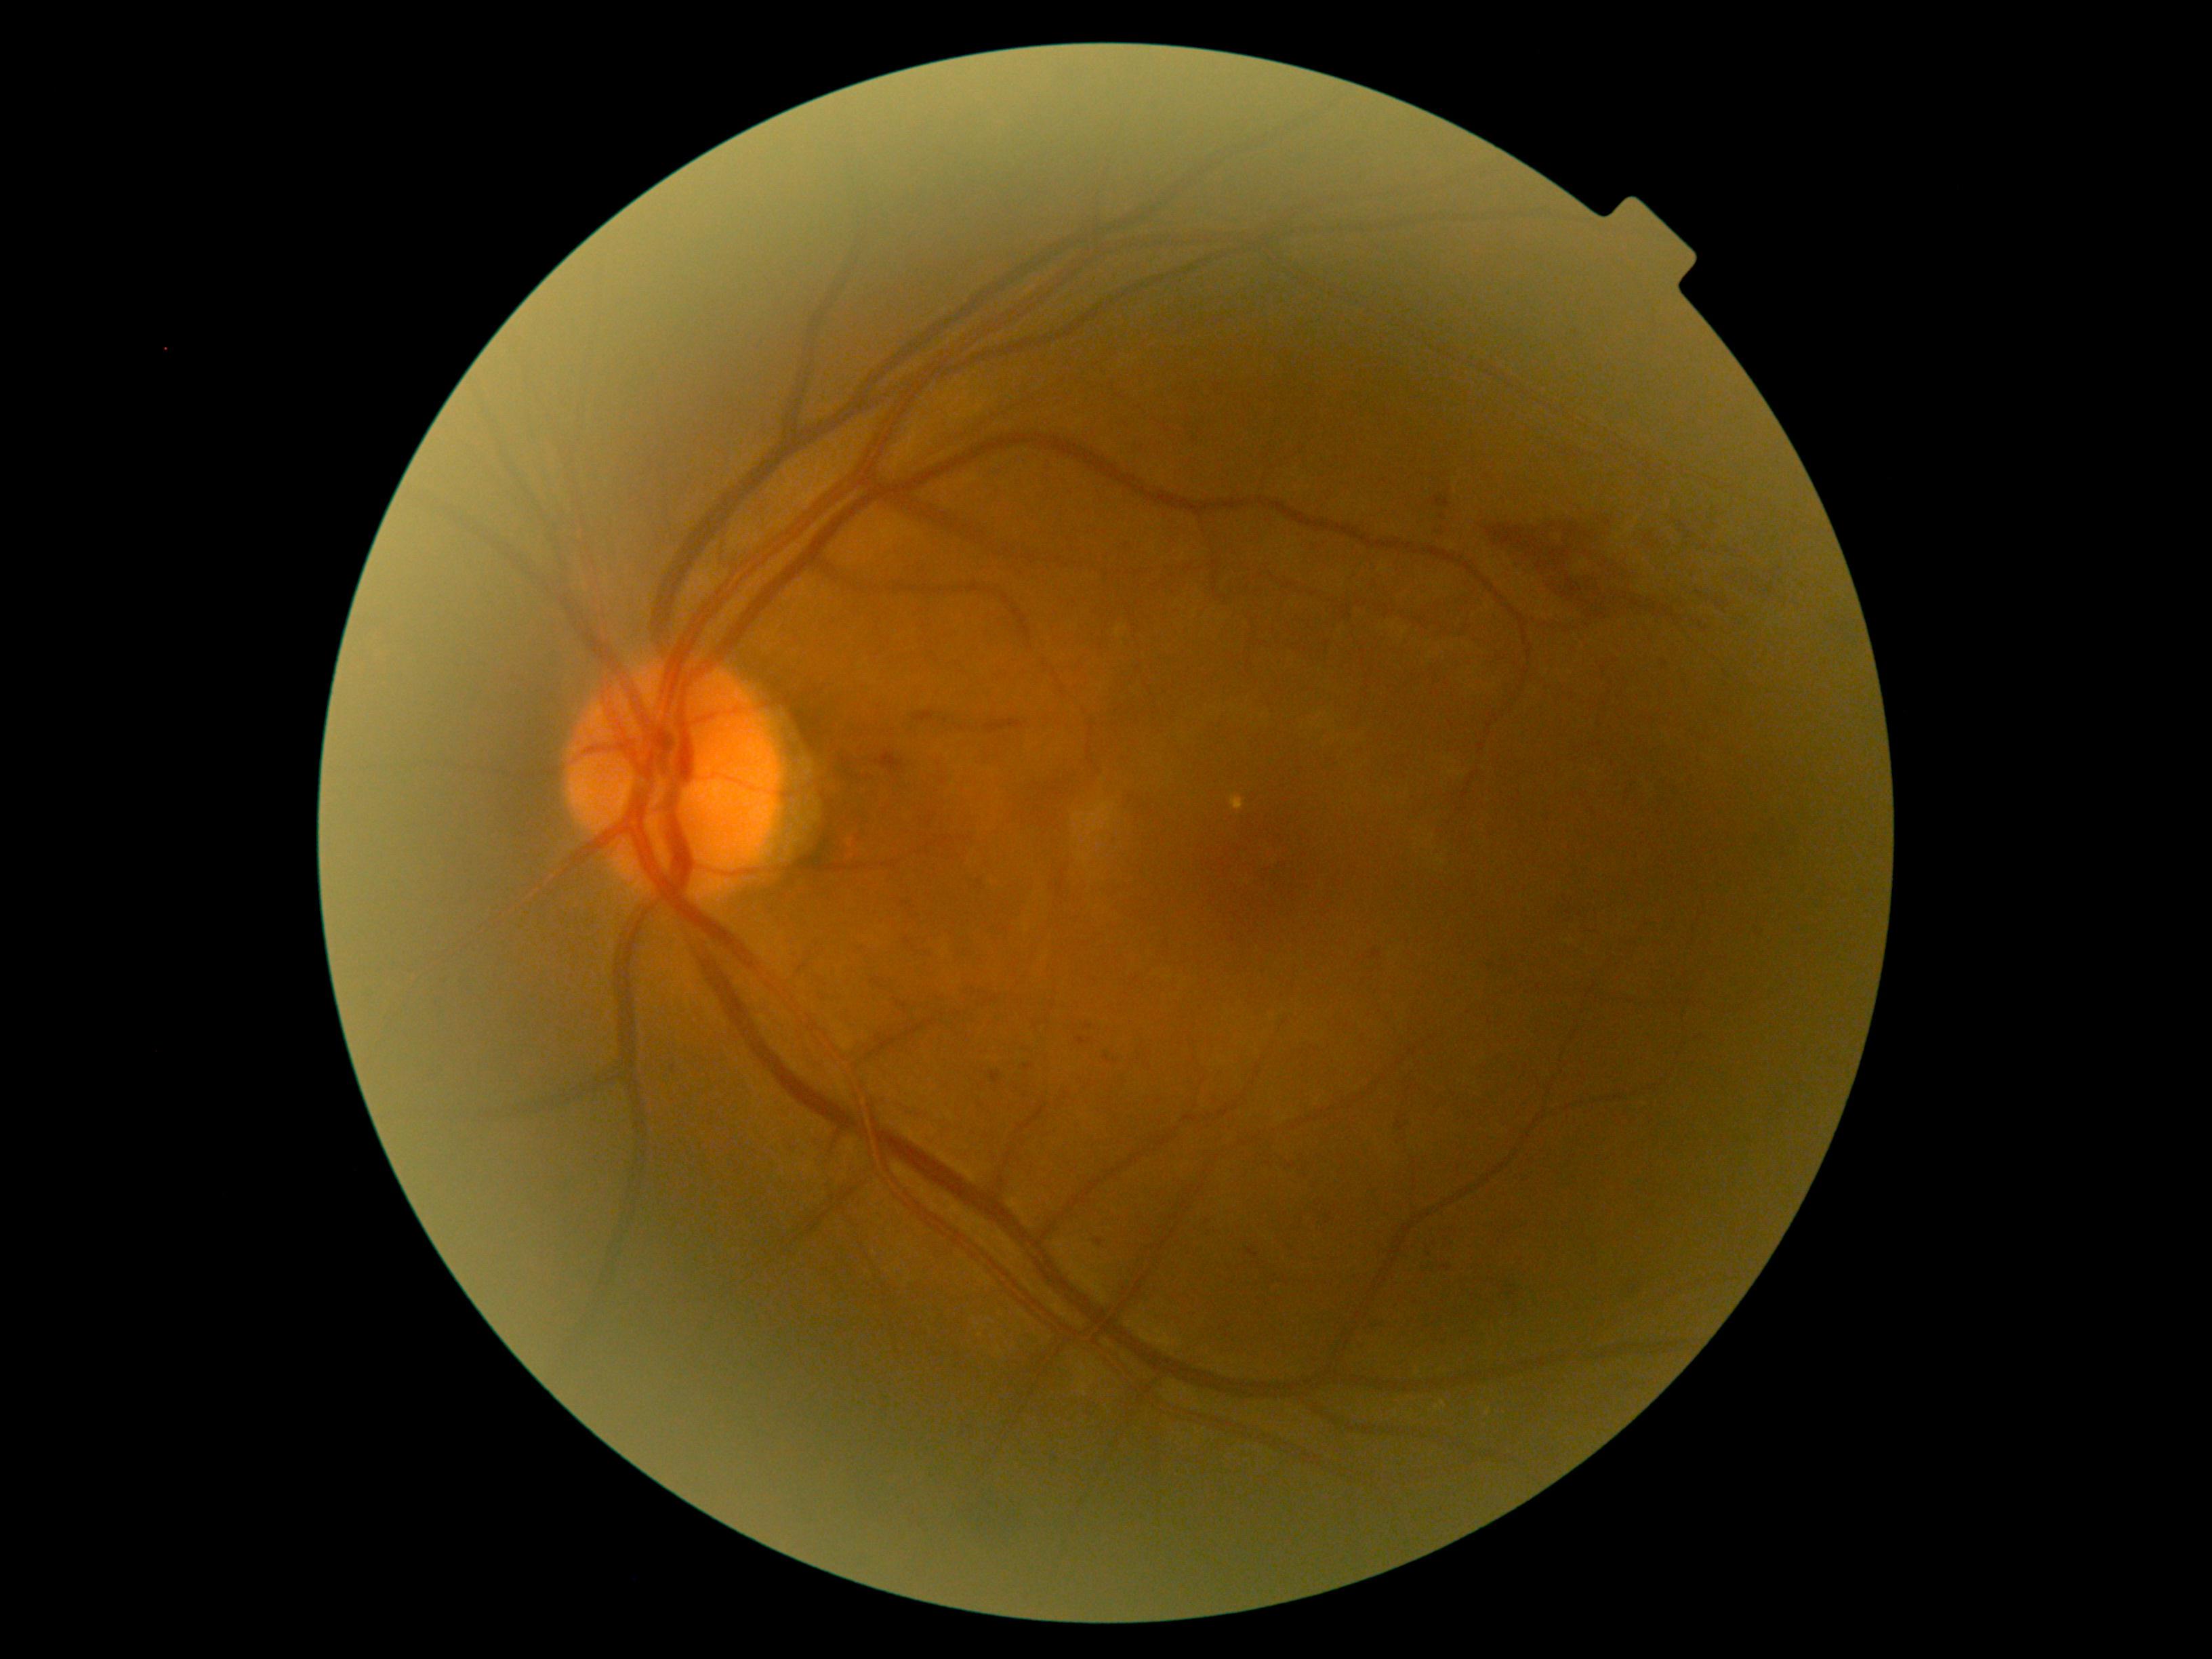
DR severity is grade 2 — more than just microaneurysms but less than severe NPDR
A subset of detected lesions:
HEs (more not shown): rect(985, 720, 1025, 734); rect(1076, 1038, 1094, 1046); rect(1756, 928, 1763, 936); rect(1395, 1115, 1406, 1131); rect(1620, 1271, 1645, 1303); rect(1483, 509, 1805, 647); rect(1570, 451, 1582, 459); rect(913, 710, 937, 723); rect(1661, 659, 1668, 669); rect(1371, 949, 1383, 960); rect(1249, 1248, 1260, 1258); rect(1288, 1162, 1296, 1169); rect(1440, 1267, 1452, 1272)
Smaller HEs around (1443; 517); (944; 721); (1149; 1067)
MAs: not present
EXs: not present
SEs: not present